848 x 848 pixels. NIDEK AFC-230 fundus camera. 45° field of view — 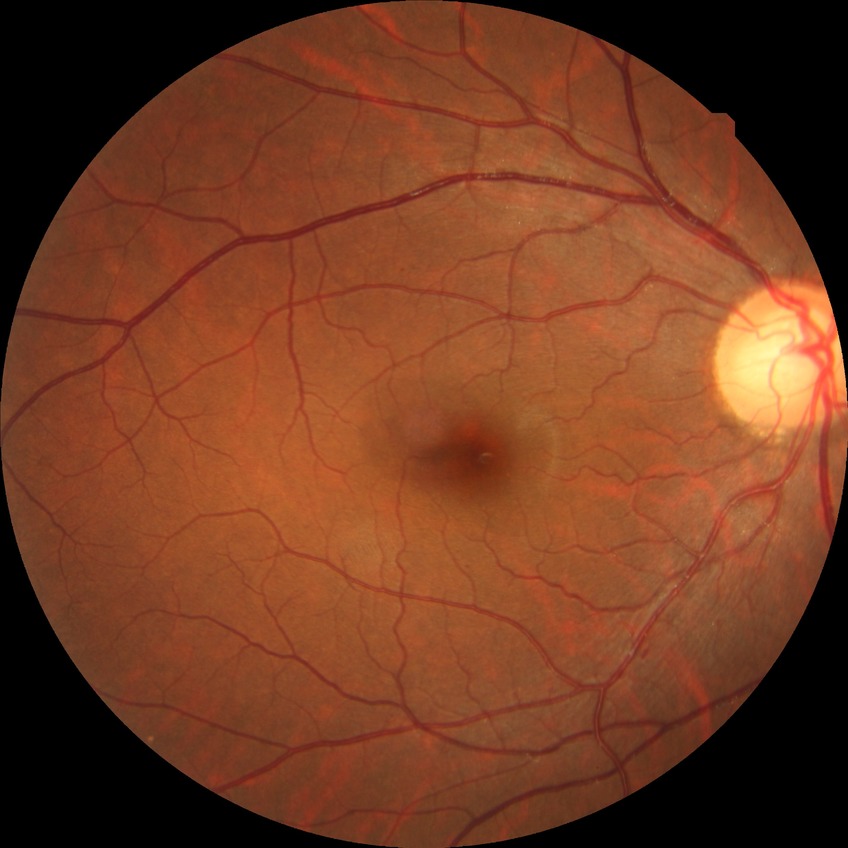

{
  "davis_grade": "no diabetic retinopathy"
}